45° FOV. Retinal fundus photograph. 2352x1568 — 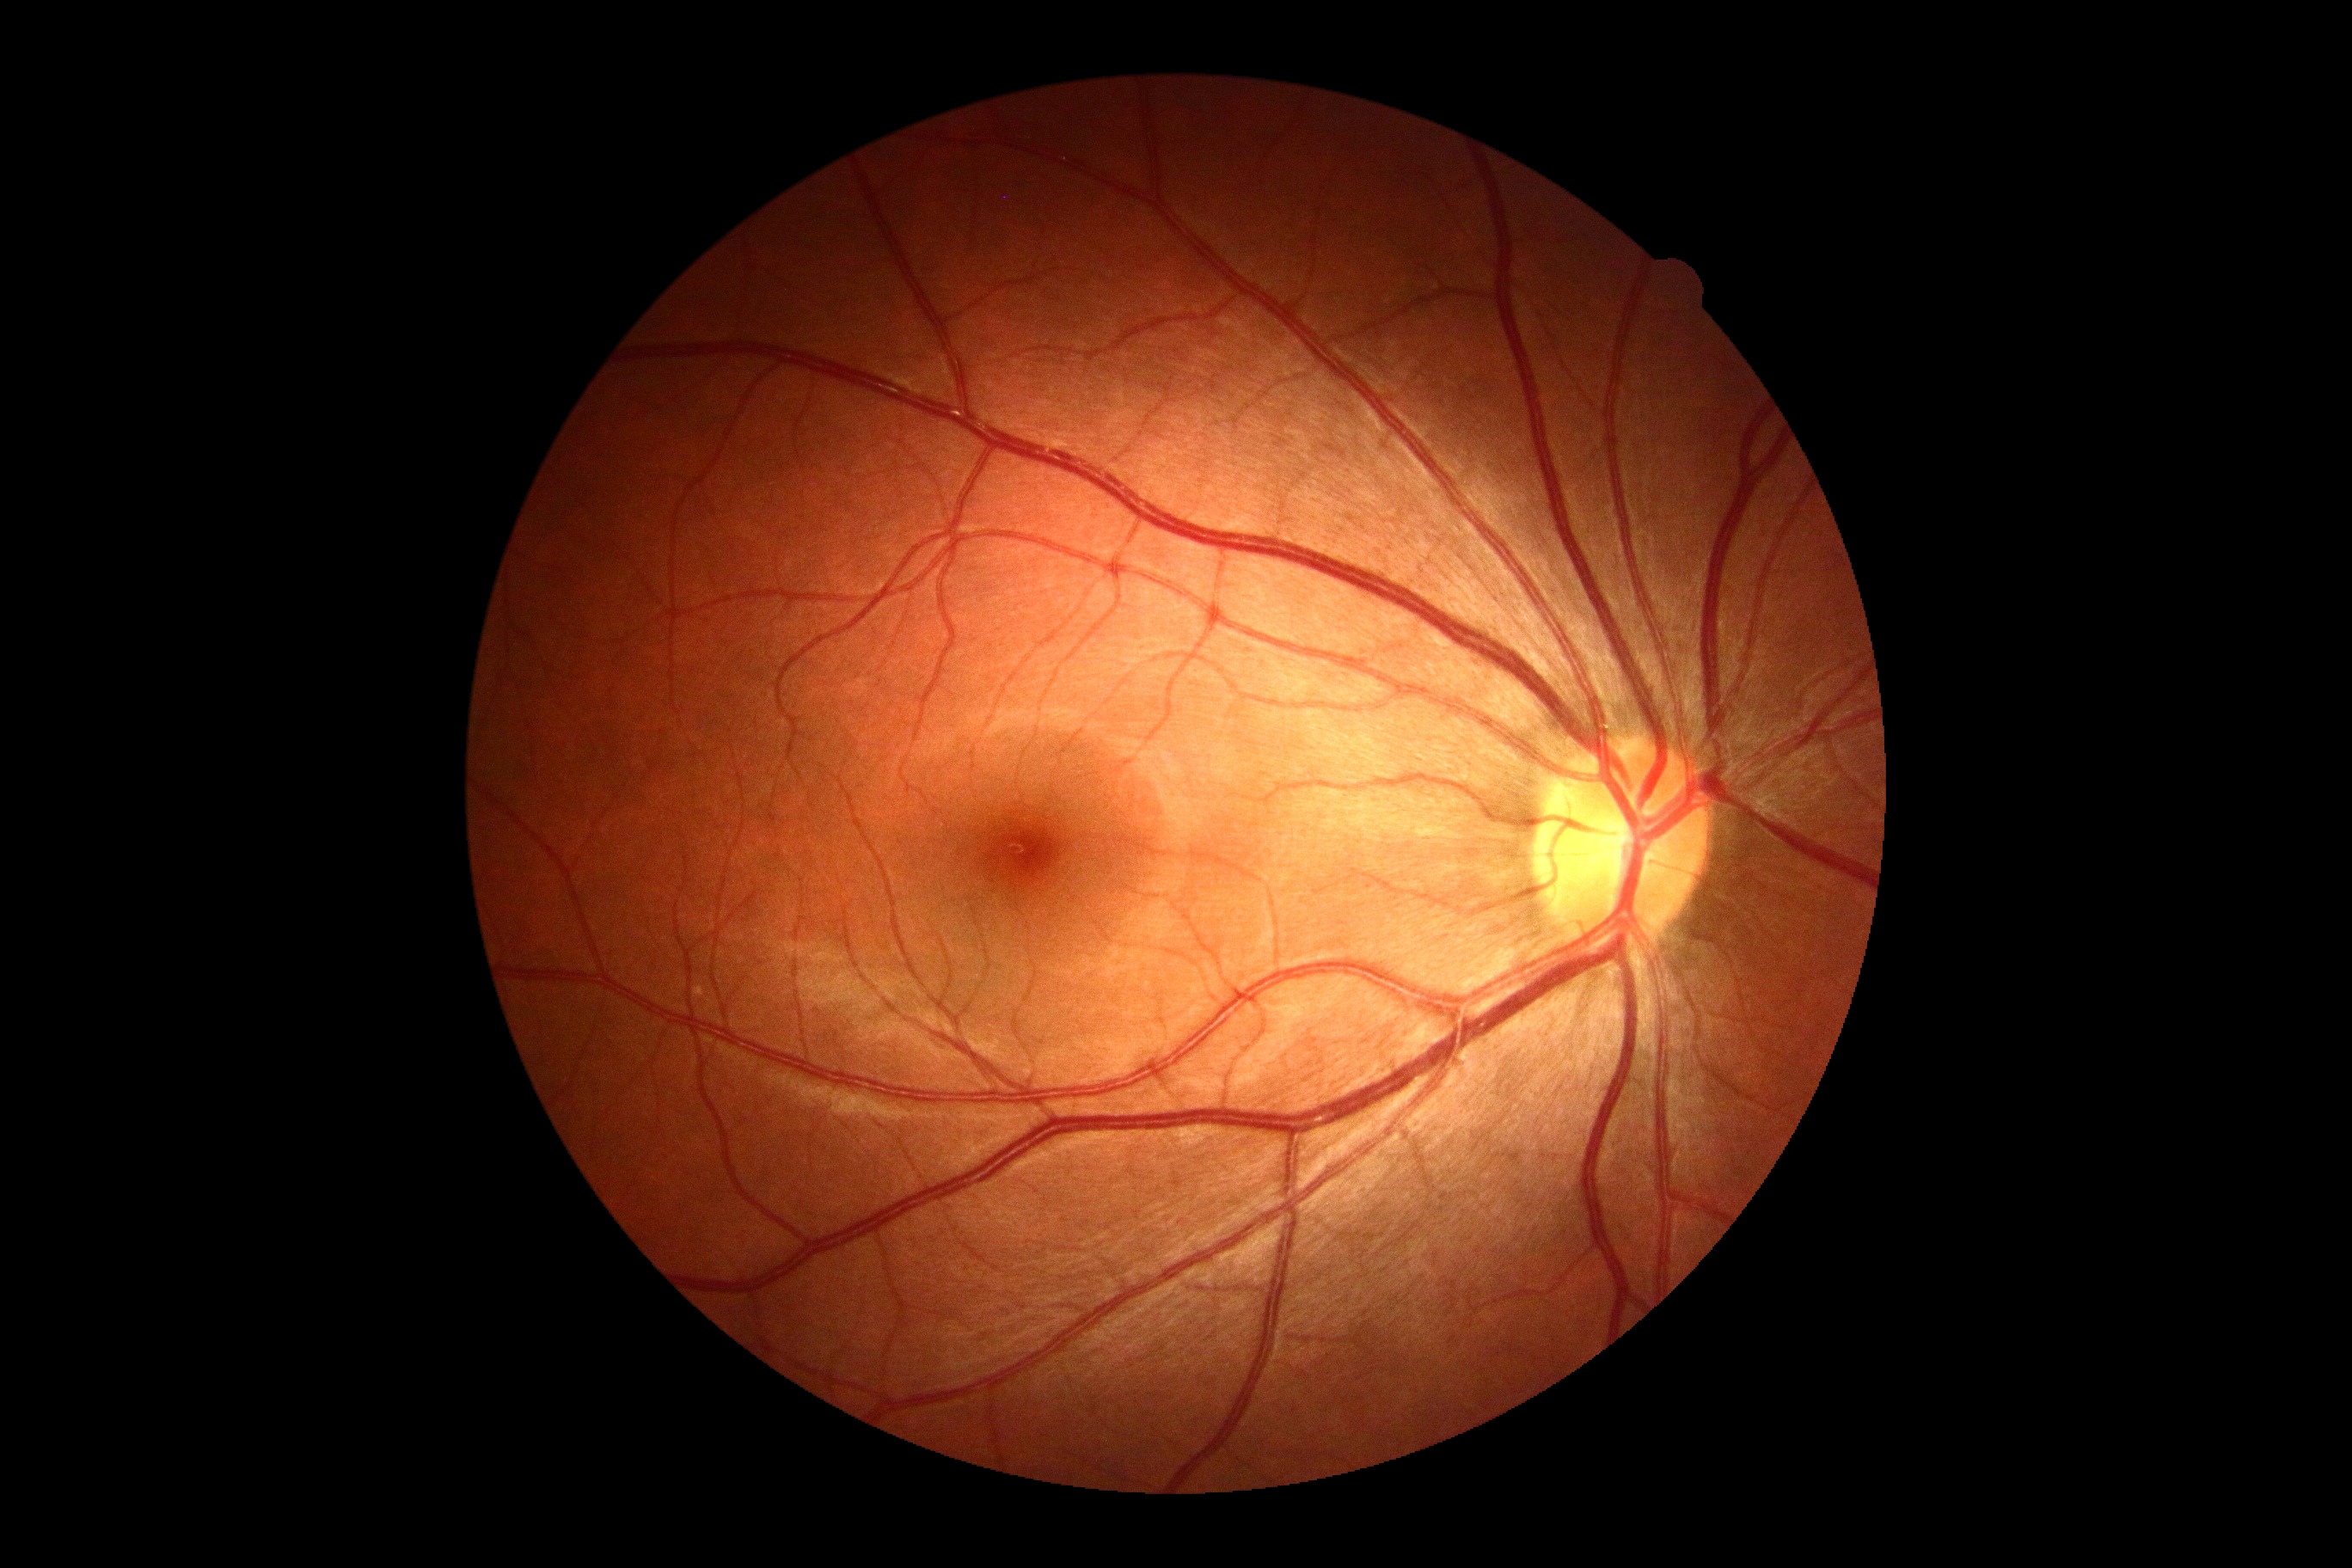

No signs of diabetic retinopathy. DR is no apparent diabetic retinopathy (grade 0).